1659x2212
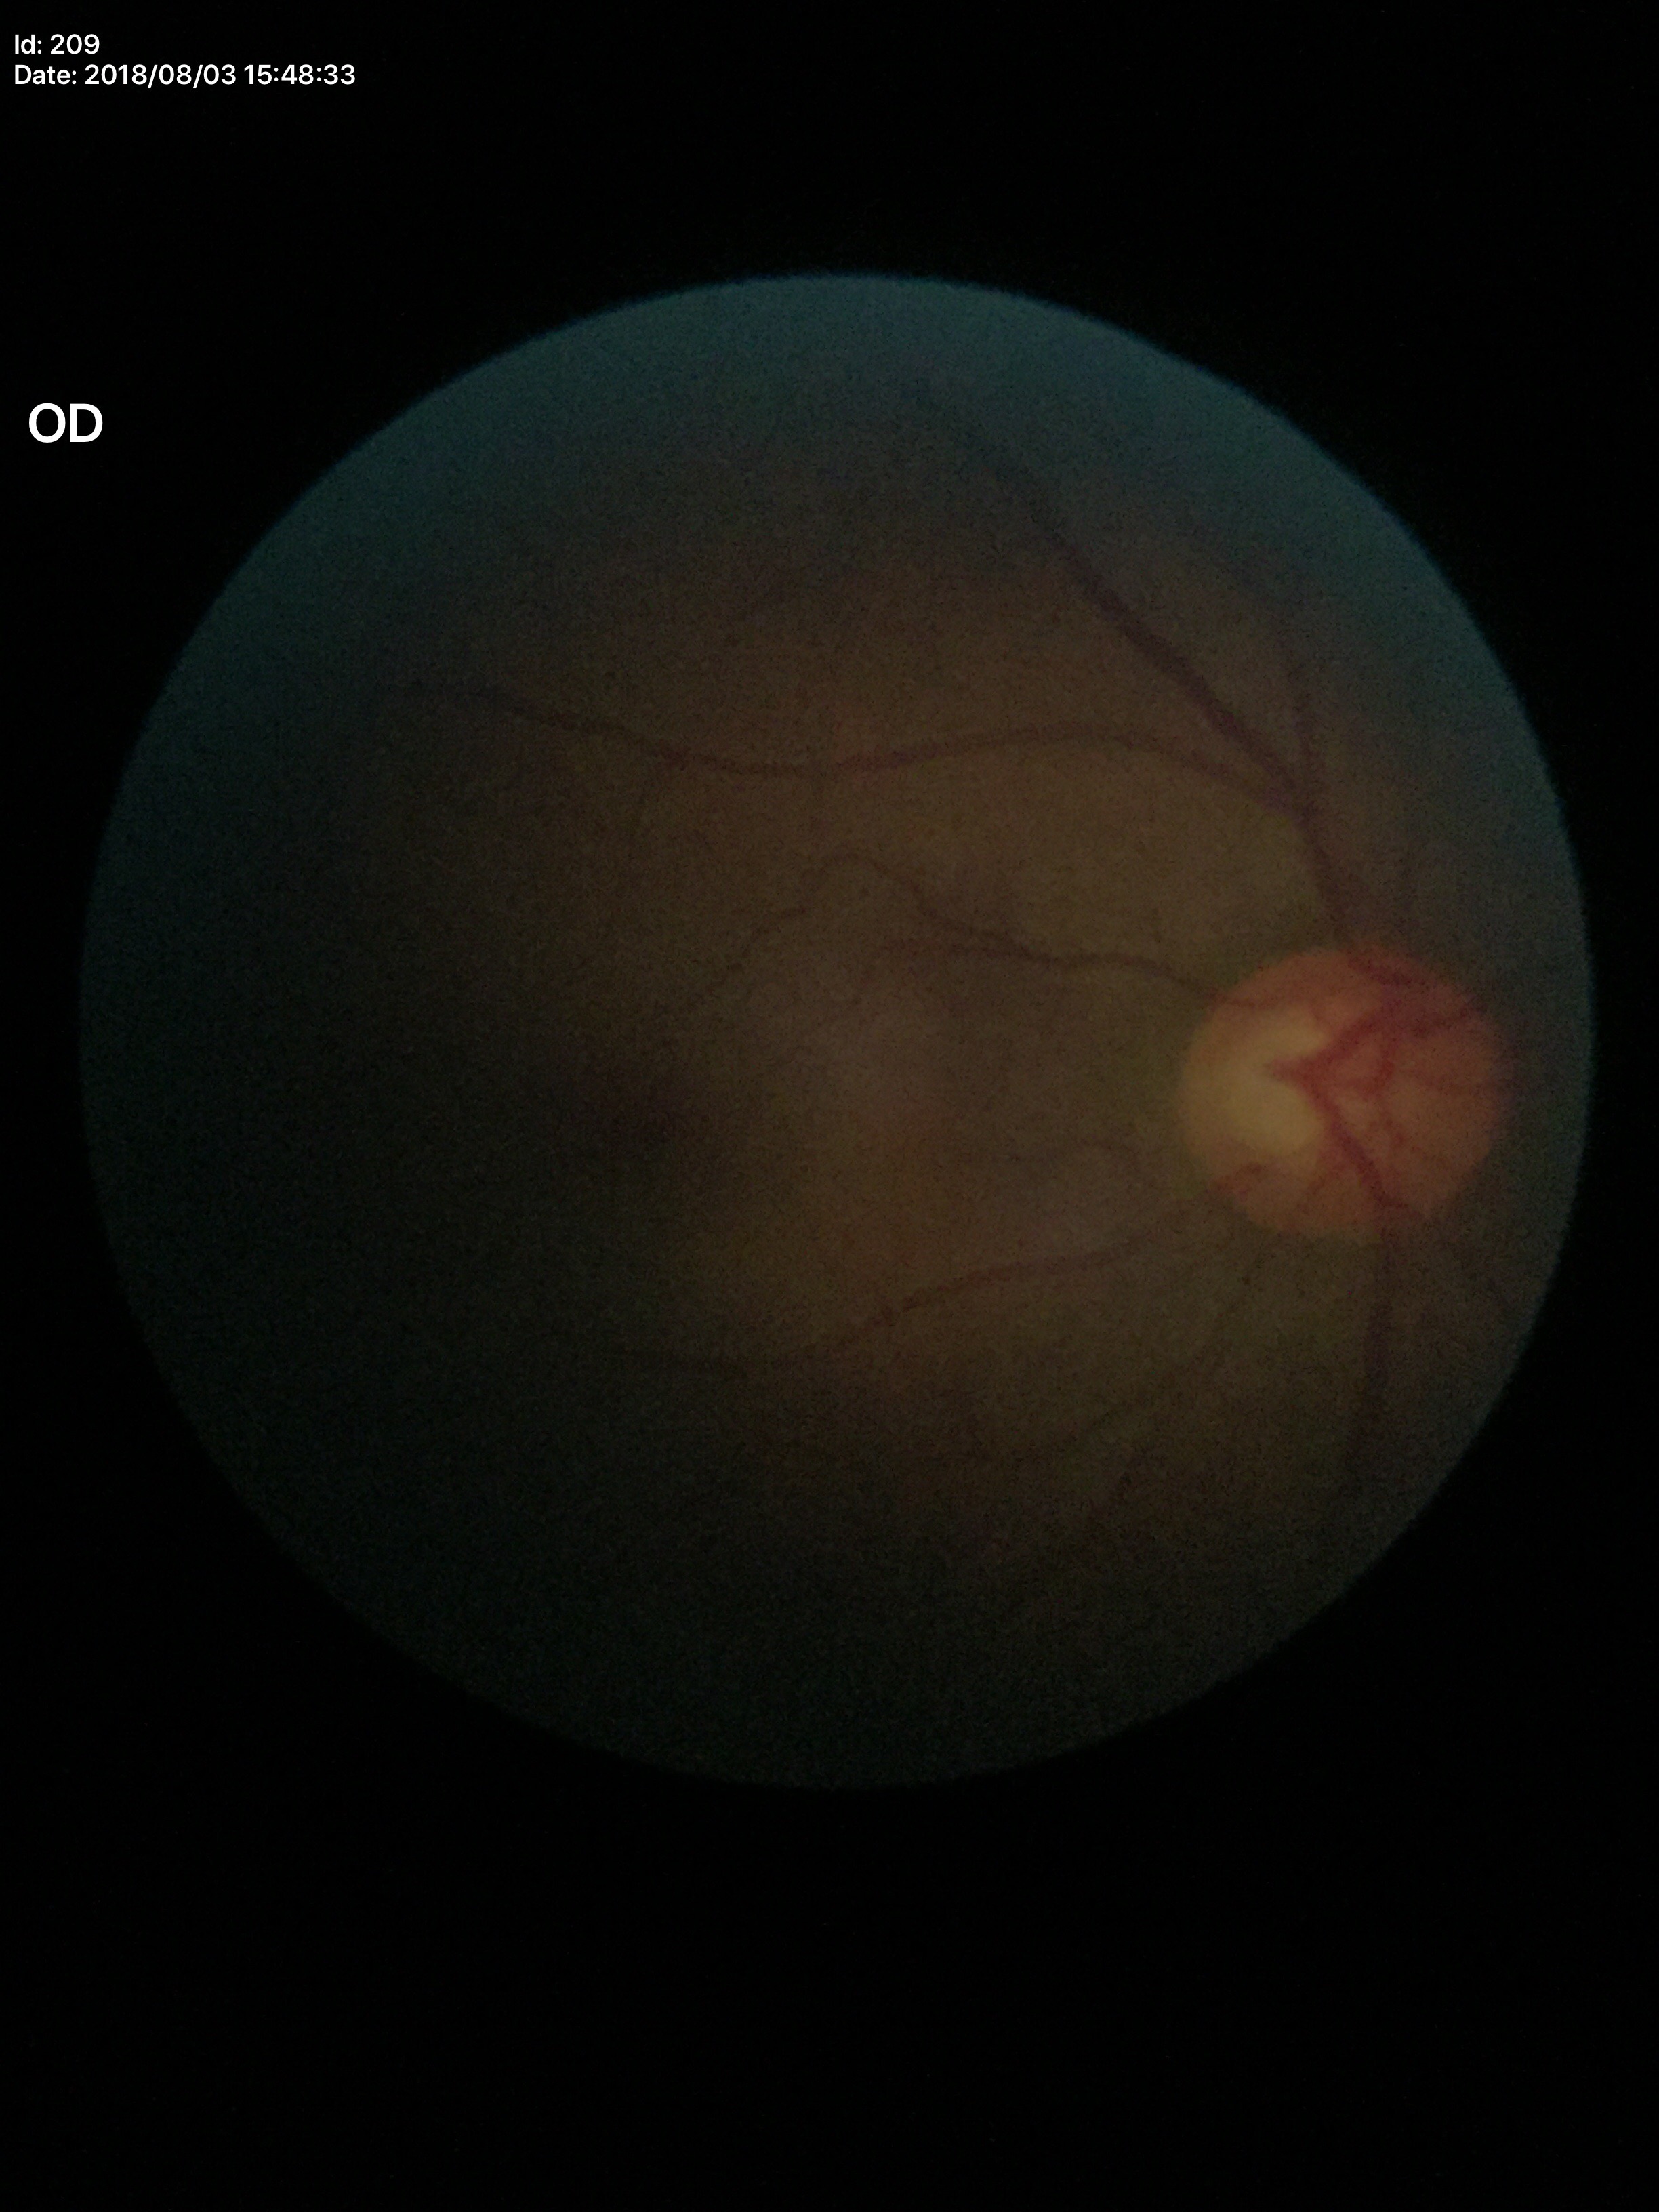
Q: What is the glaucoma assessment?
A: no suspicious findings (2/5 graders called glaucoma suspect)
Q: What is the VCDR?
A: 0.60